Ultra-widefield (UWF) fundus image — 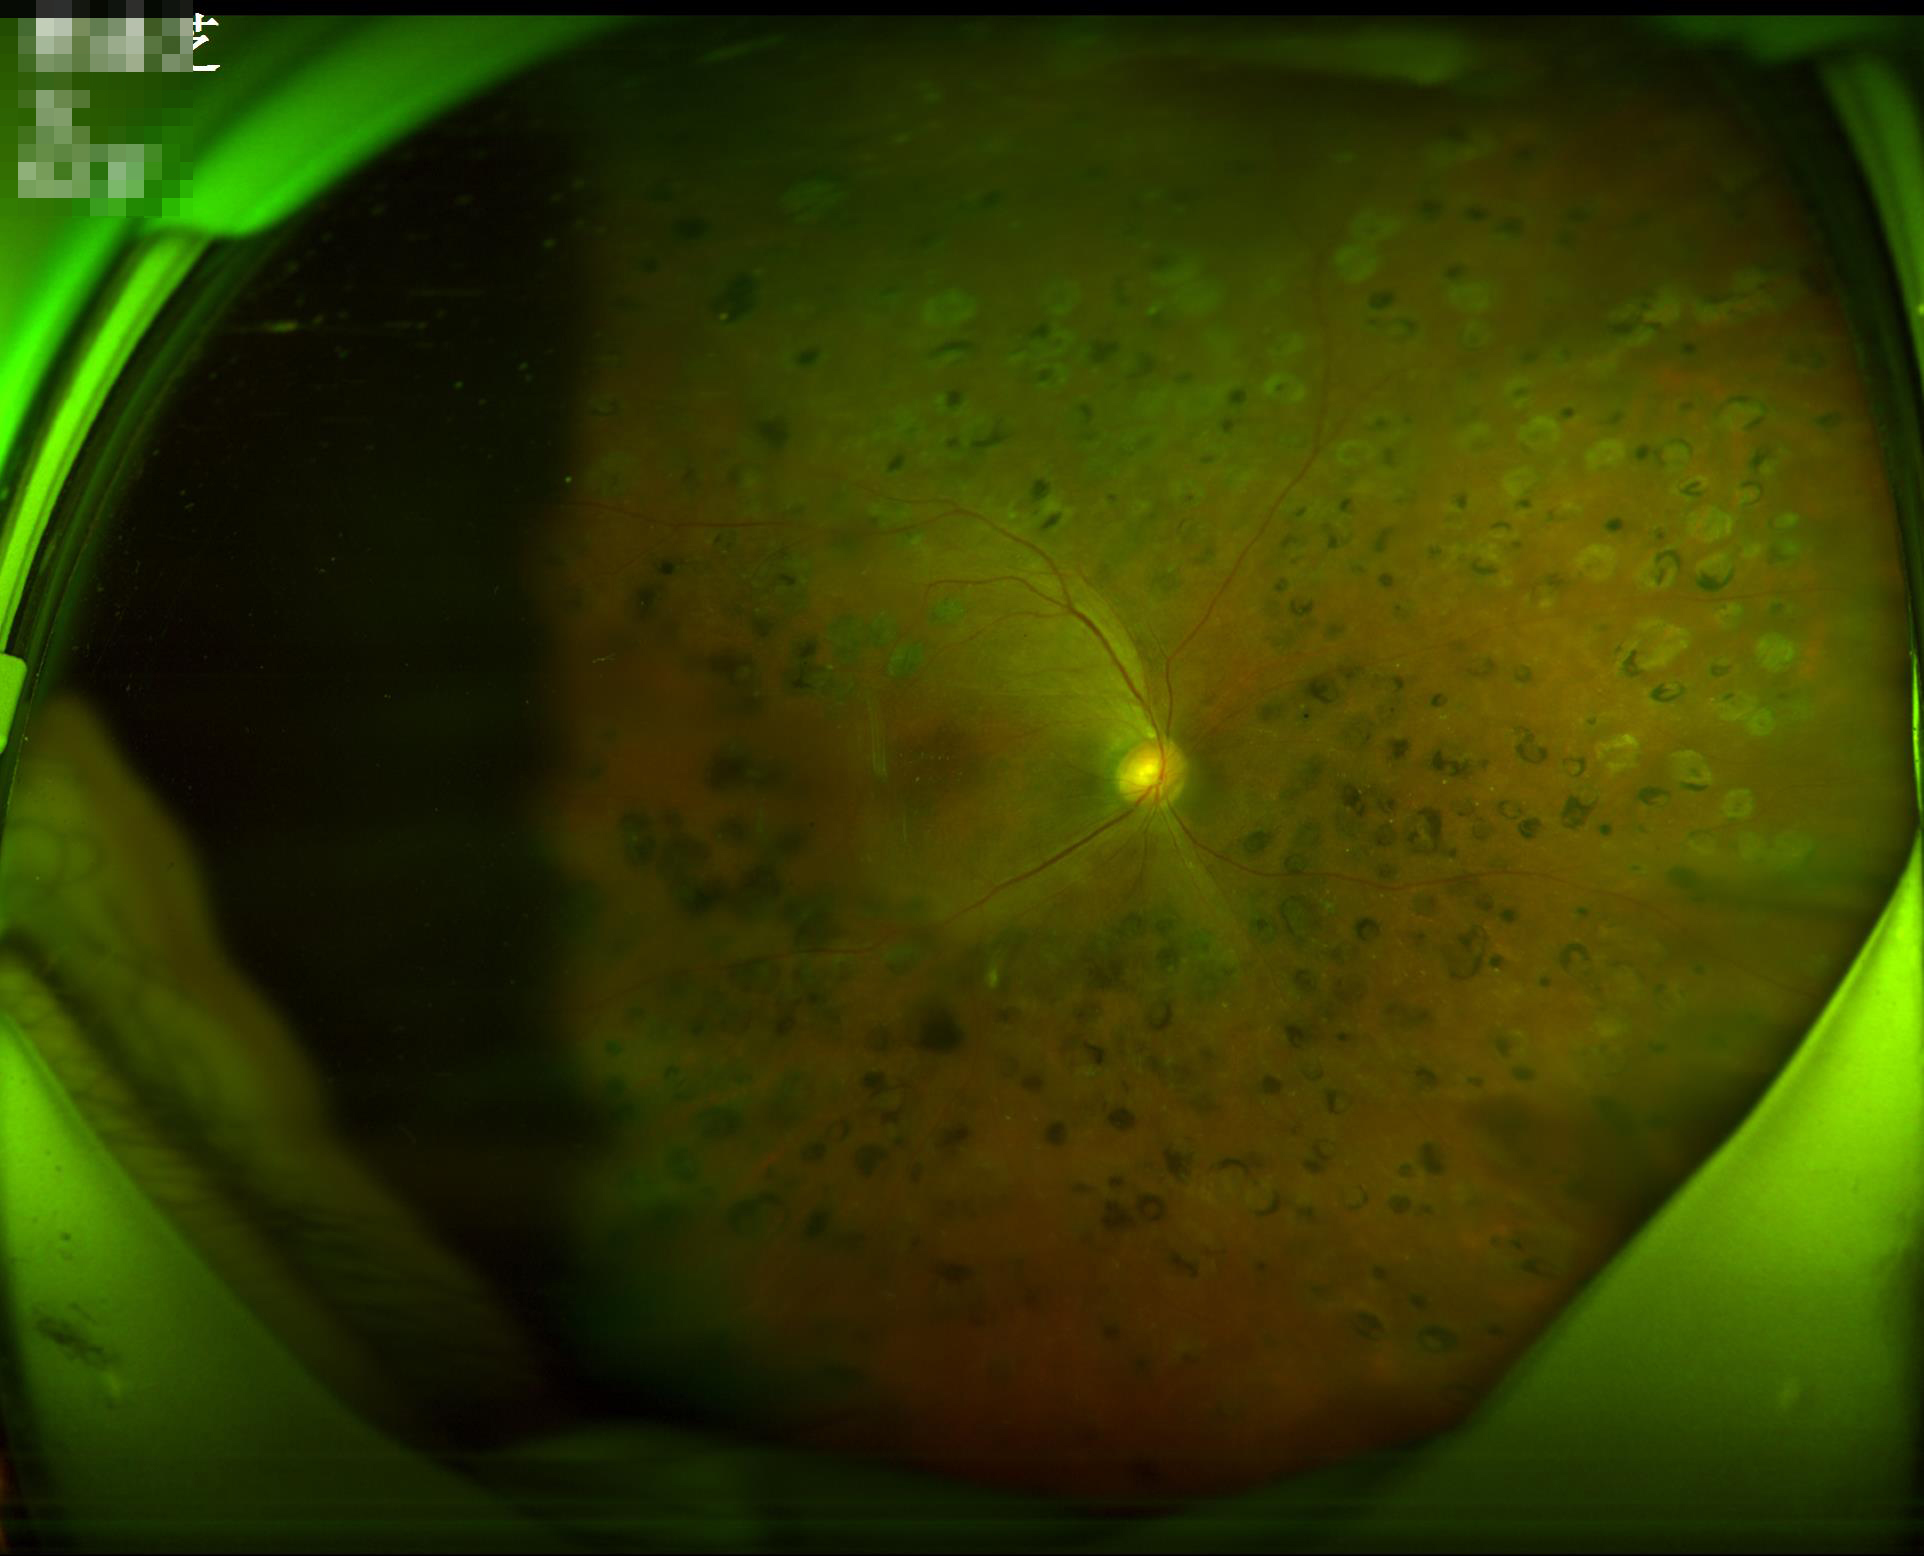
Image quality: overall: suboptimal; contrast: reduced; illumination: poor.